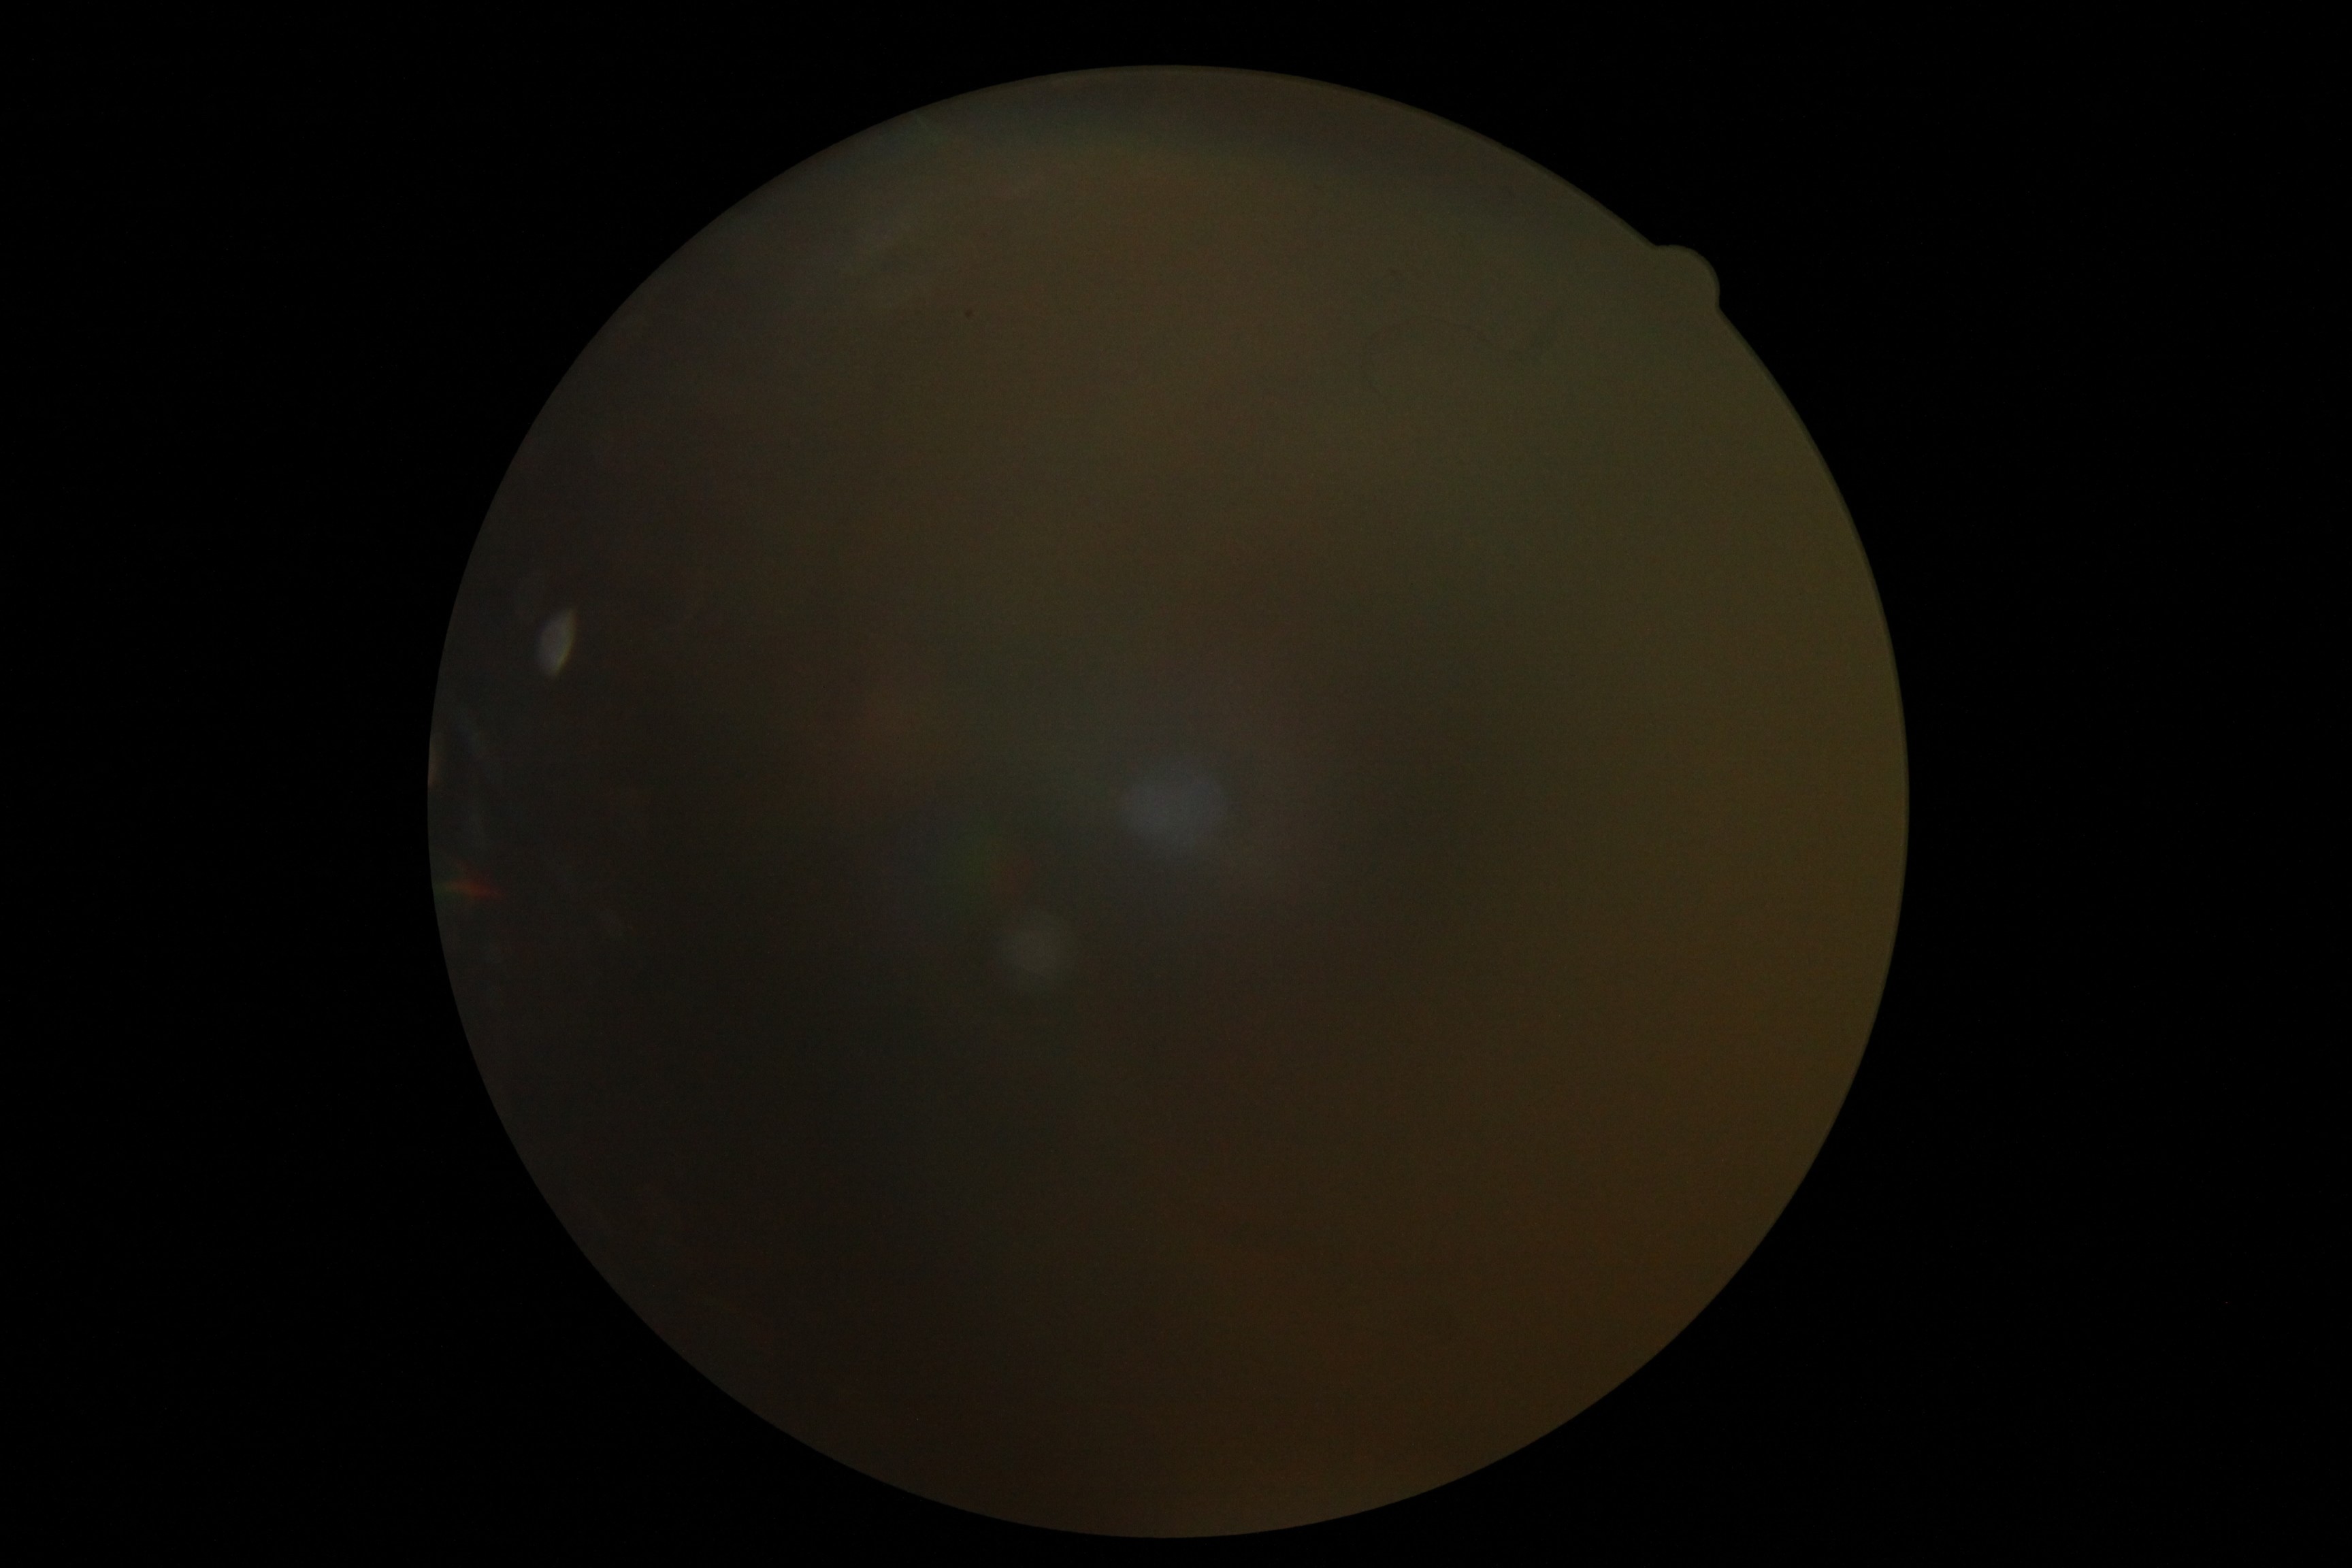
diabetic retinopathy severity@ungradable.